848x848; retinal fundus photograph; 45° FOV; no pharmacologic dilation.
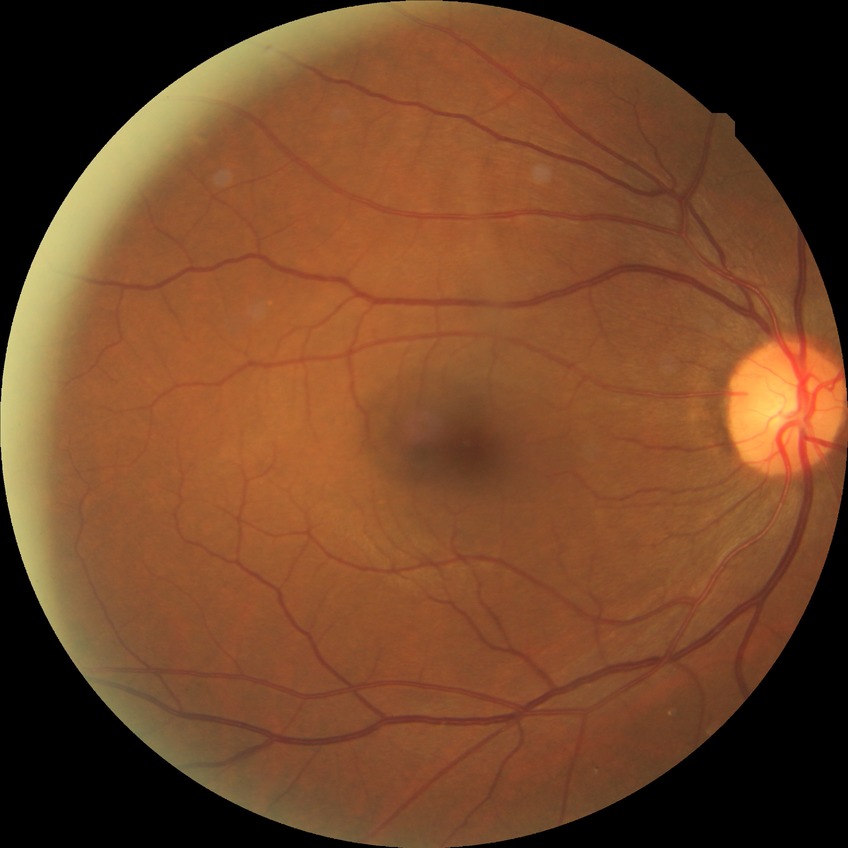
{"davis_grade": "NDR (no diabetic retinopathy)"}